2352 by 1568 pixels — 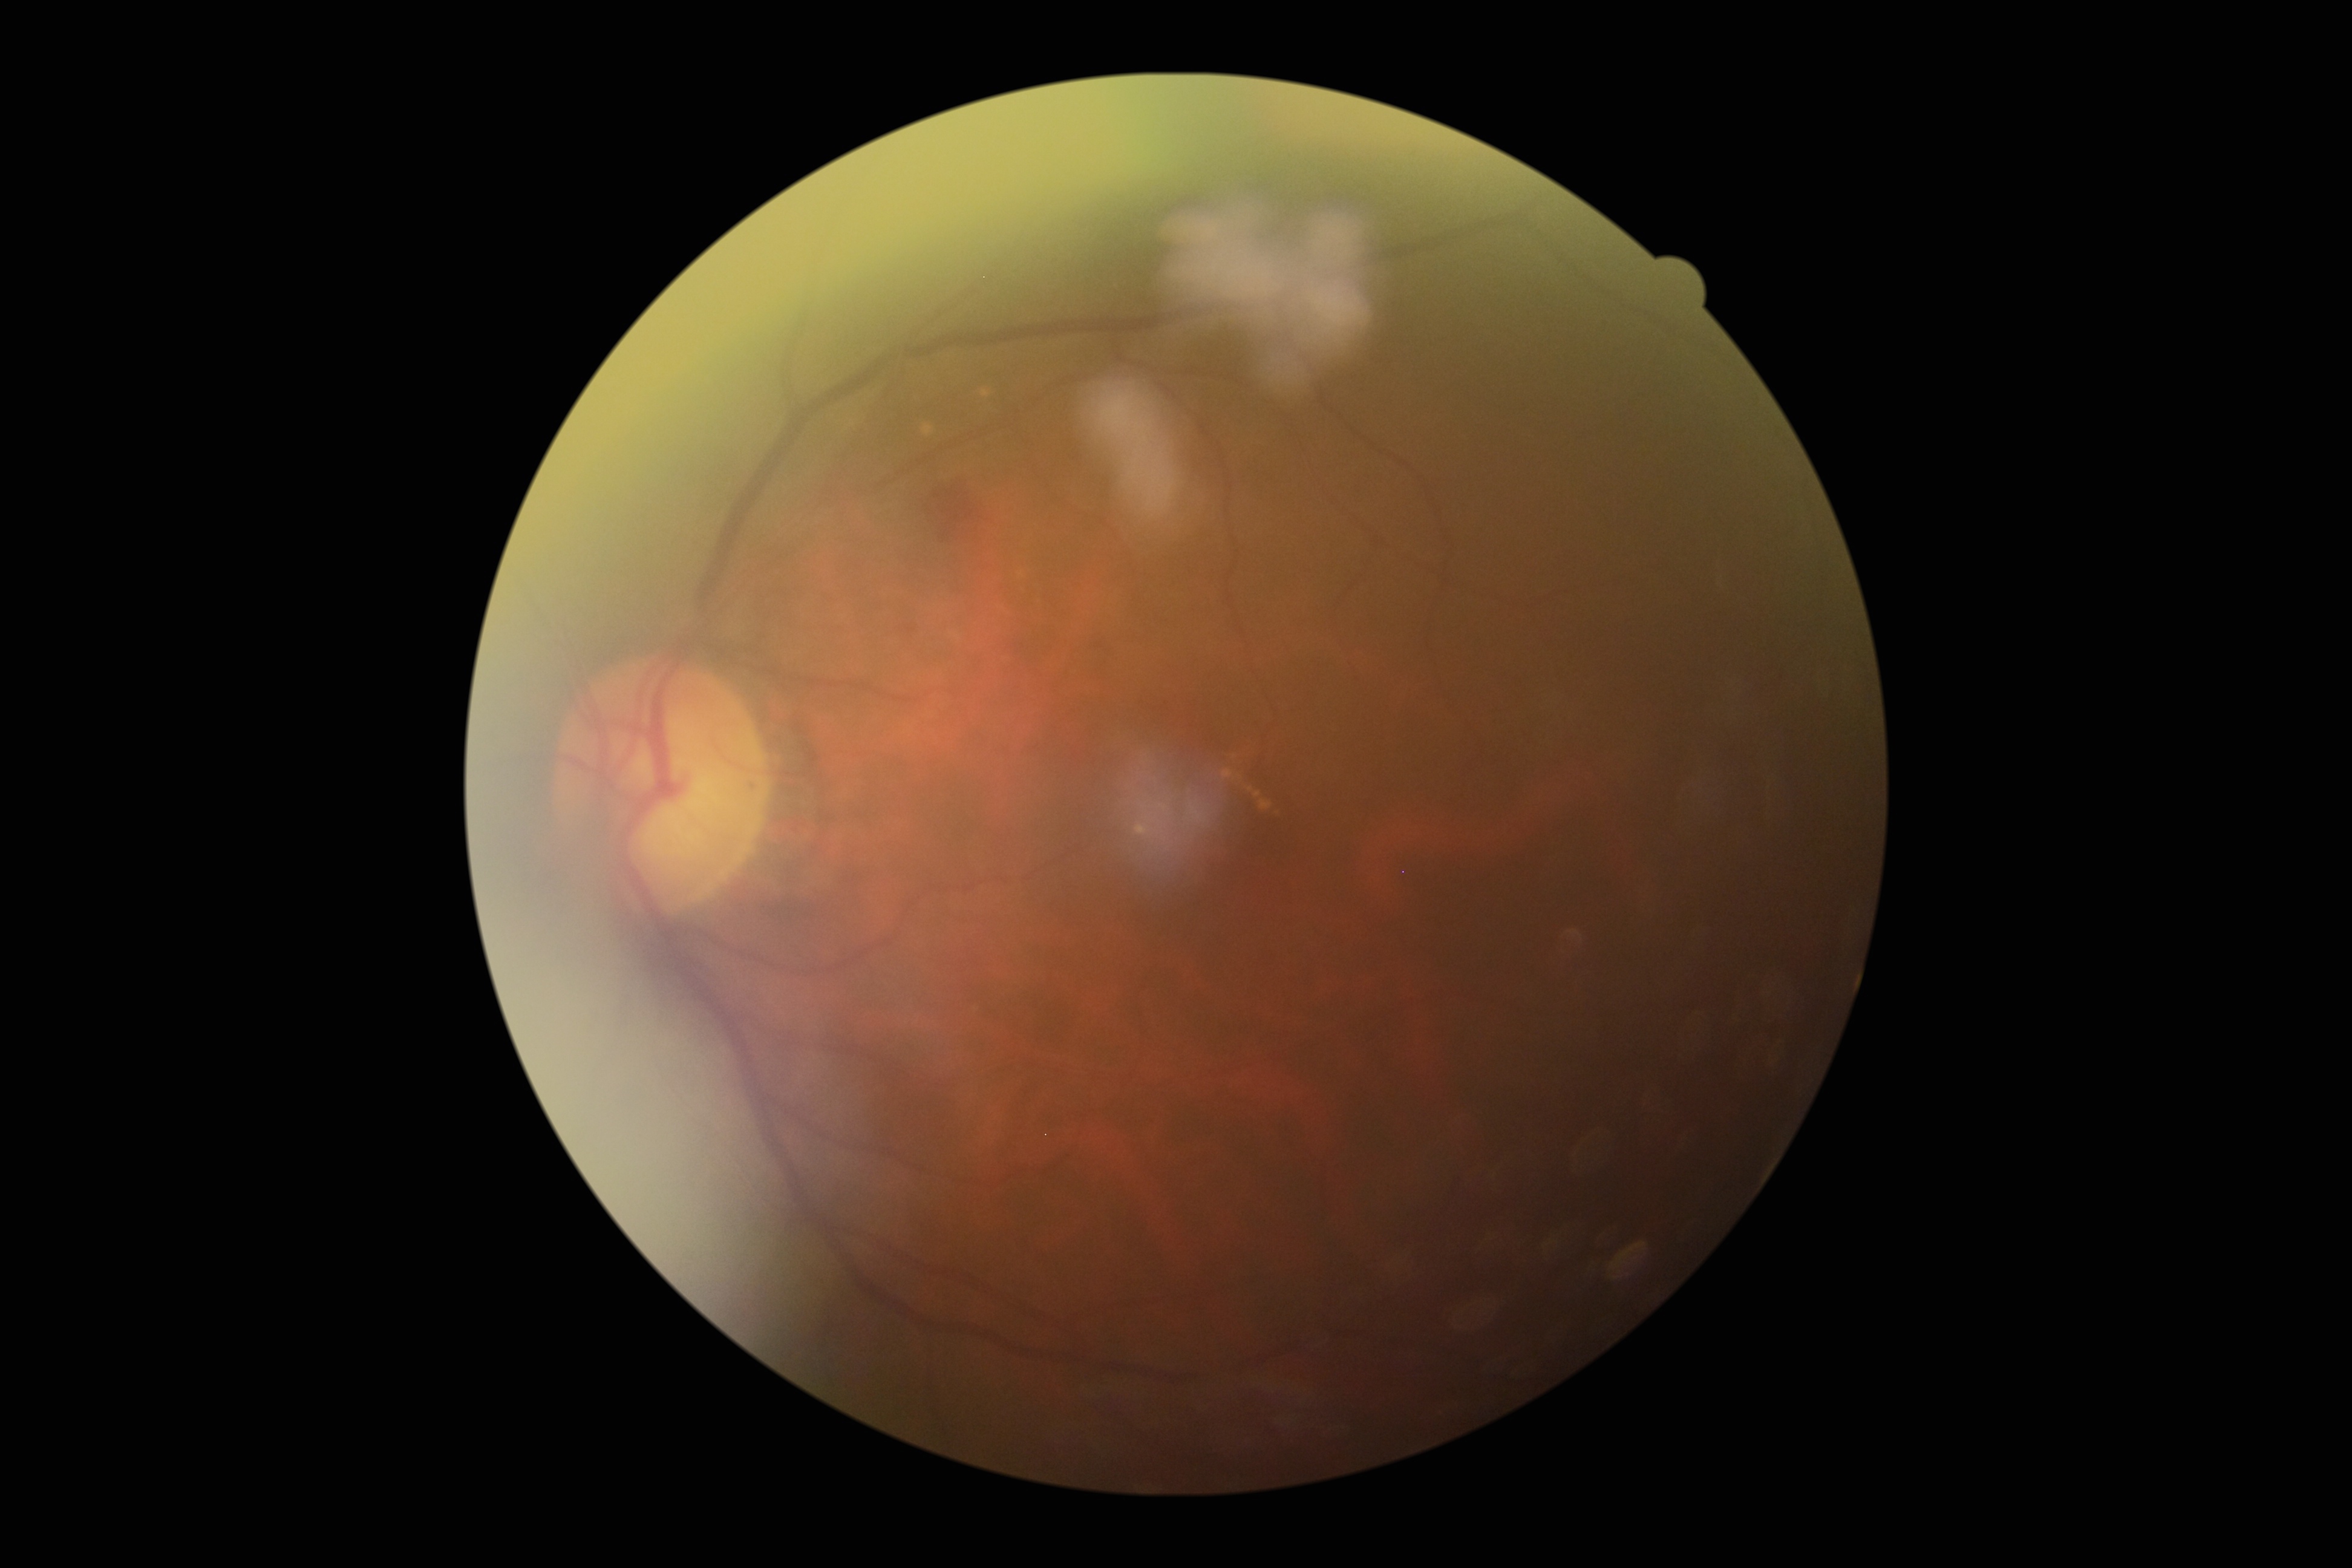

• diabetic retinopathy — moderate non-proliferative diabetic retinopathy (grade 2)
• DR class — non-proliferative diabetic retinopathy